Infant wide-field retinal image
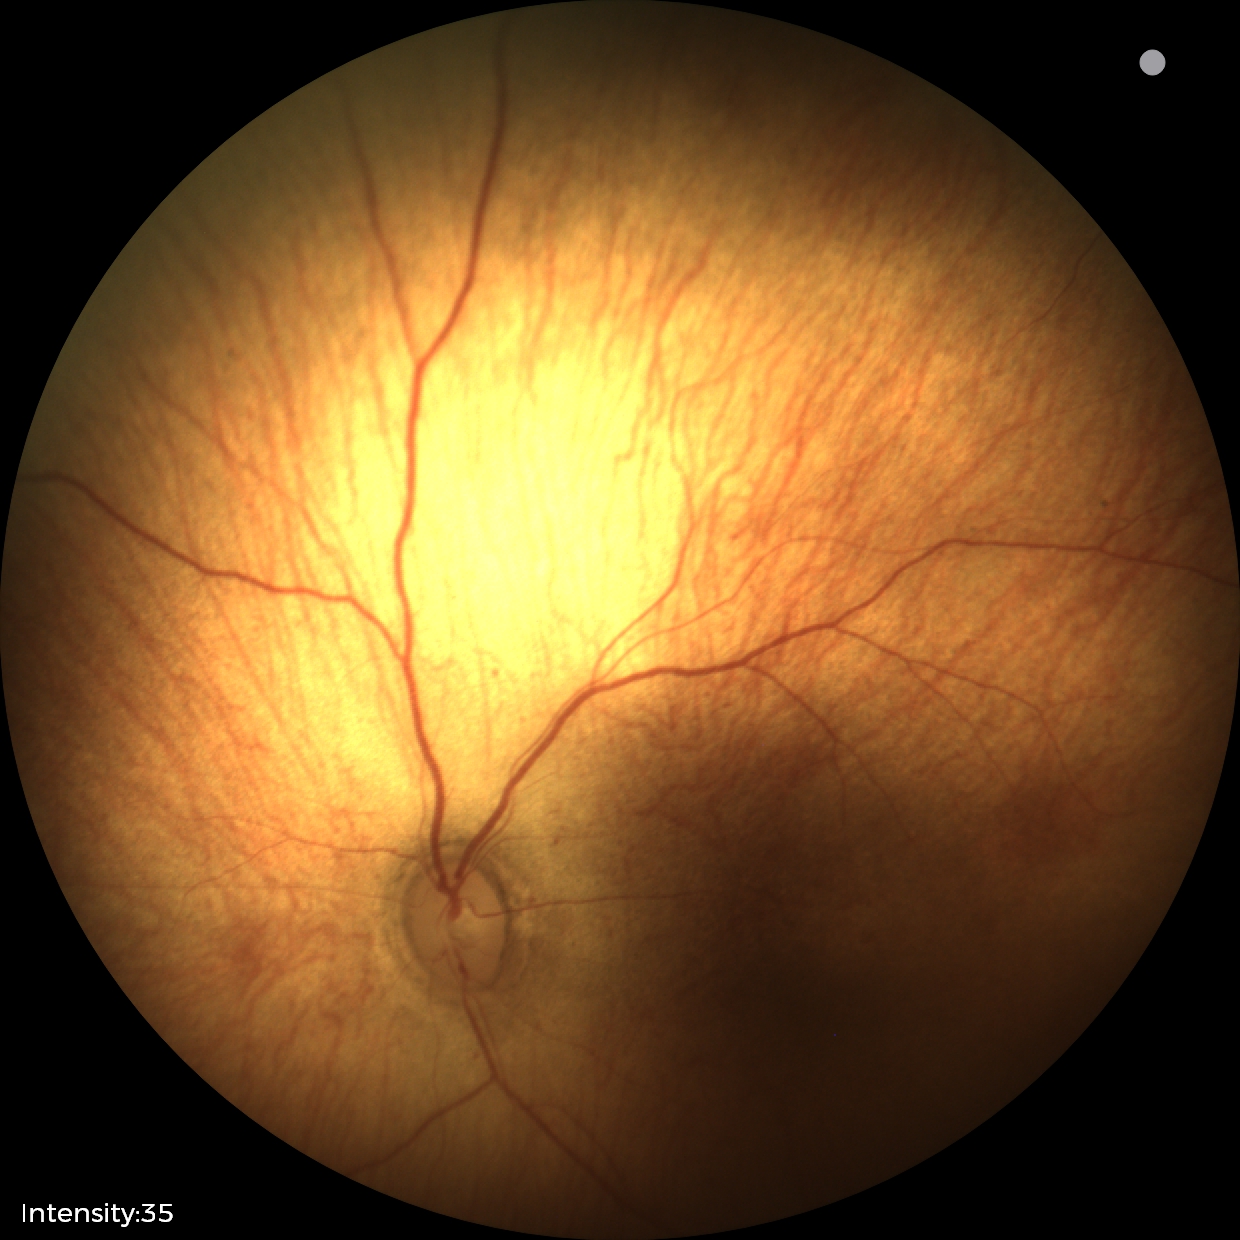

No plus disease. Screening examination consistent with status post ROP — retinal appearance after treated retinopathy of prematurity.